Fundus photo; image size 240x240:
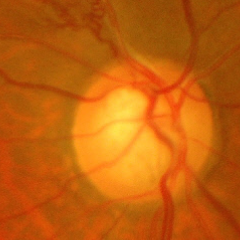 Glaucomatous optic neuropathy is present. Glaucoma stage: advanced glaucomatous optic neuropathy.